45-degree field of view.
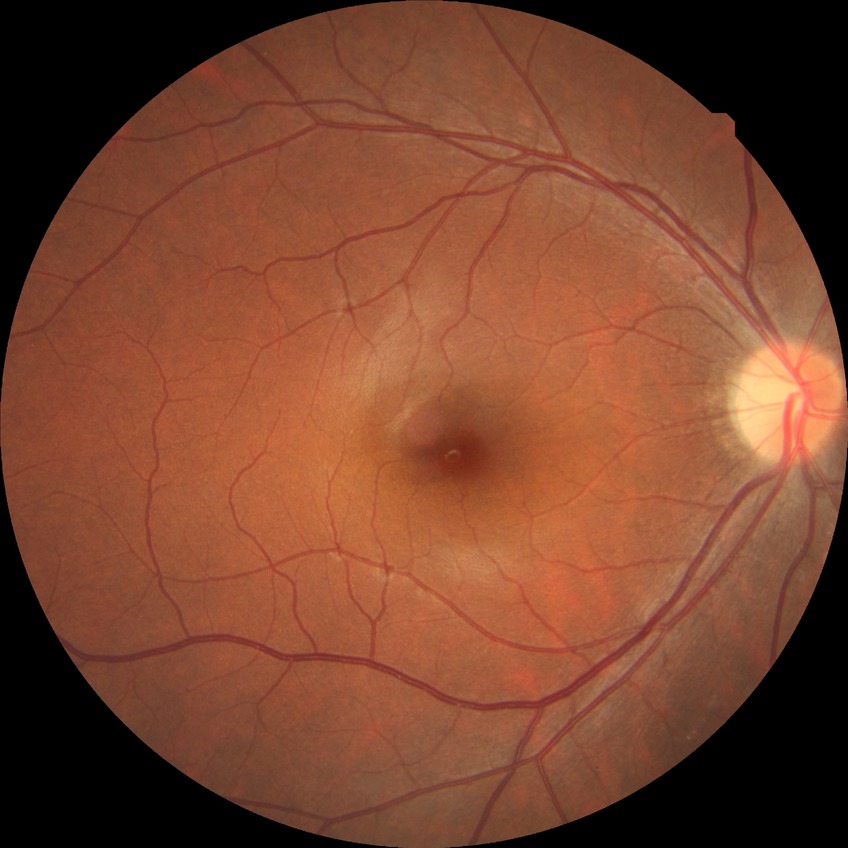
Diabetic retinopathy (DR) is no diabetic retinopathy (NDR).